RetCam wide-field infant fundus image
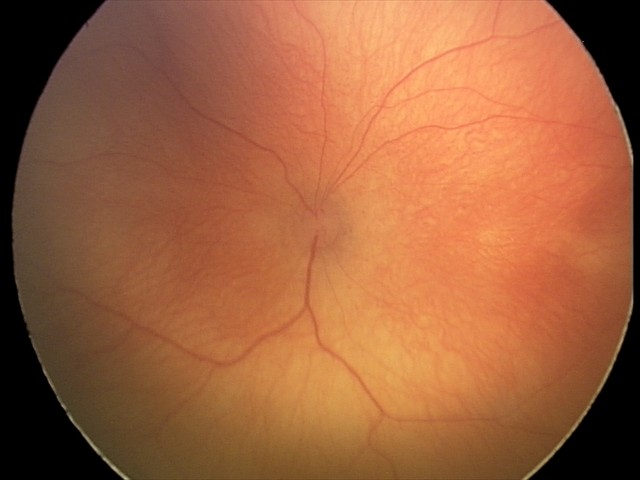

Plus disease absent.
Screening examination consistent with retinopathy of prematurity (ROP) stage 2 — ridge with height and width at the demarcation line.